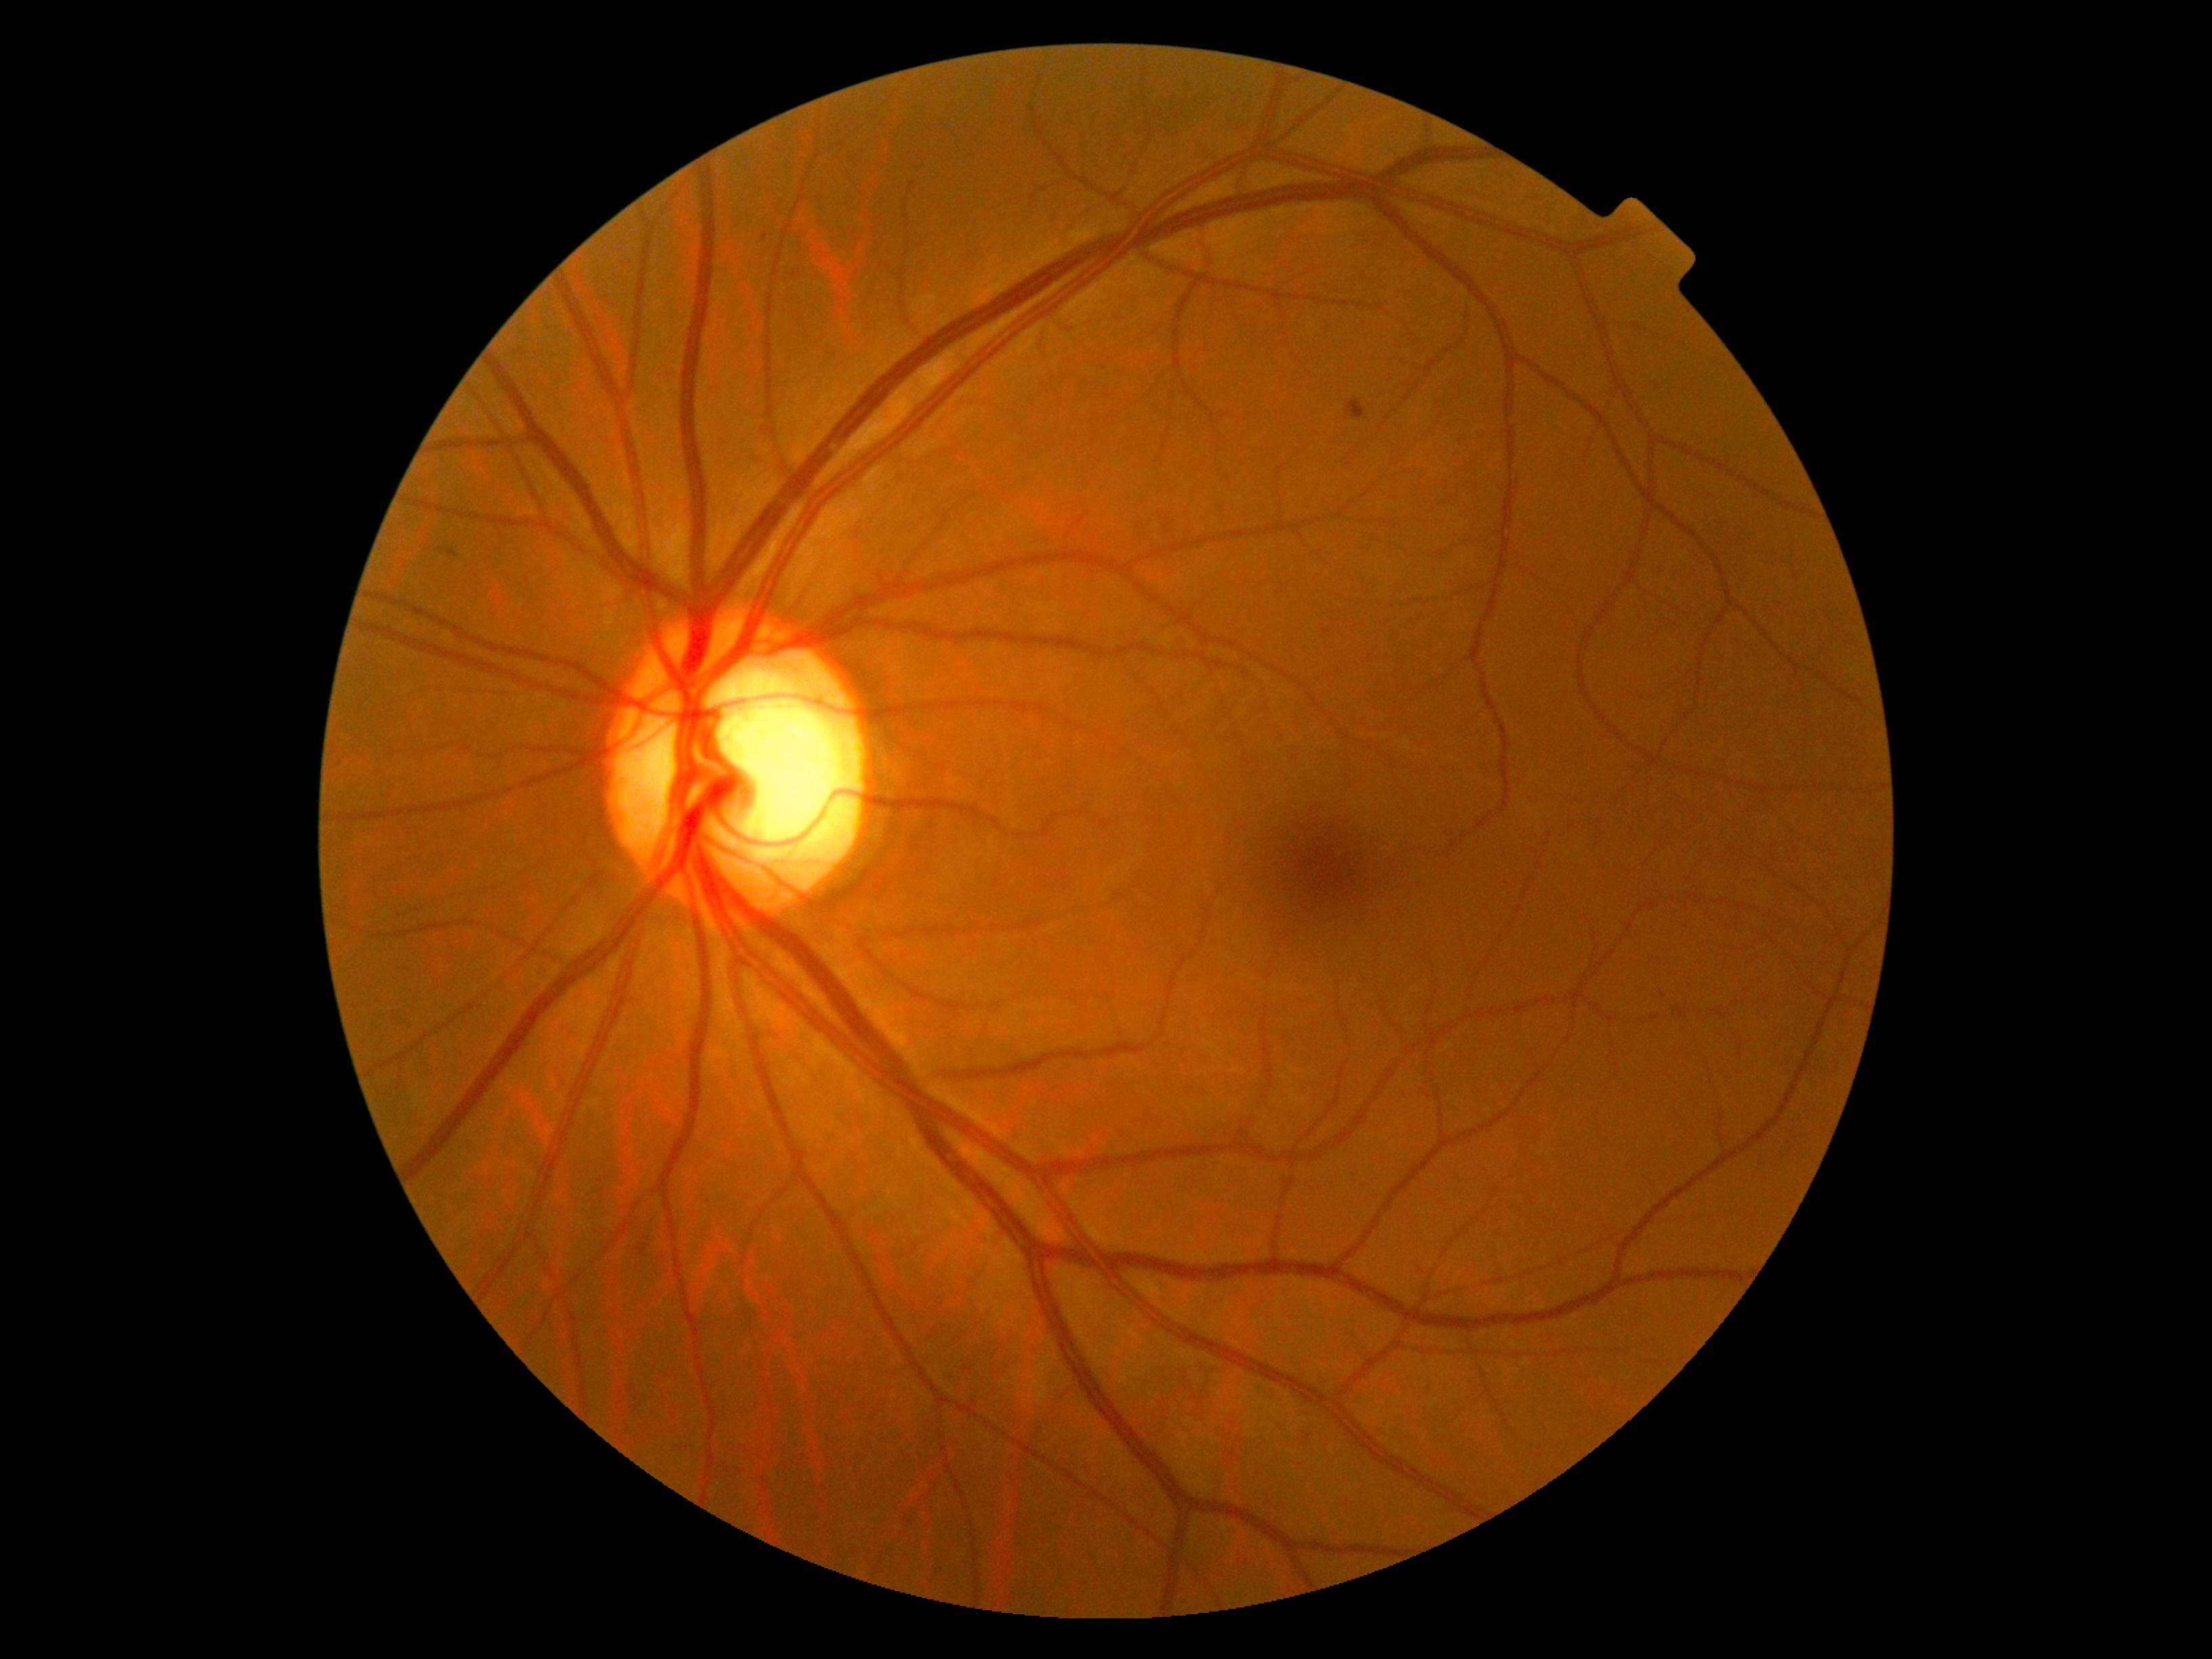
* DR — grade 2 (moderate NPDR)